Wide-field contact fundus photograph of an infant · Clarity RetCam 3, 130° FOV.
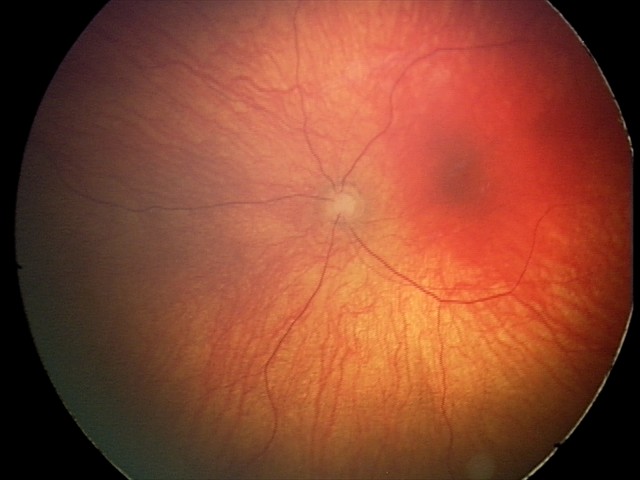 Q: What is the diagnosis from this examination?
A: optic nerve hypoplasia